Camera: NIDEK AFC-230. Without pupil dilation. Color fundus image.
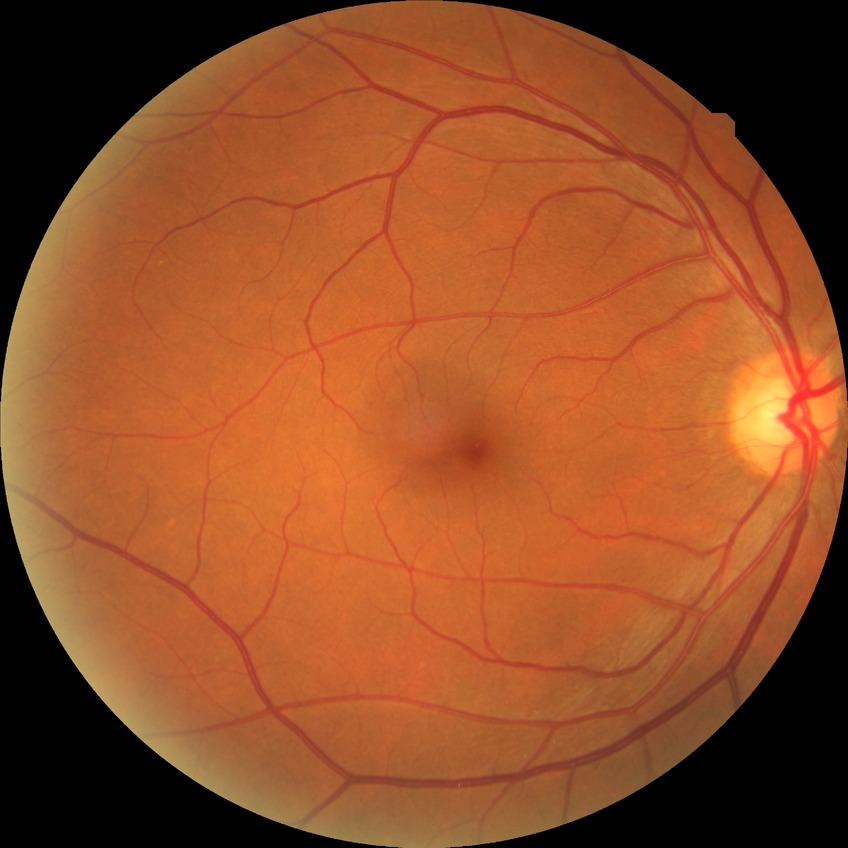 Diabetic retinopathy (DR): NDR (no diabetic retinopathy).